Nidek AFC-330: 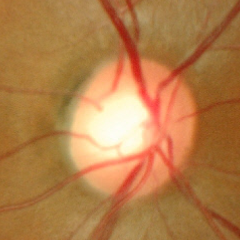
Q: Is glaucoma present?
A: No signs of glaucoma.